2228x1652:
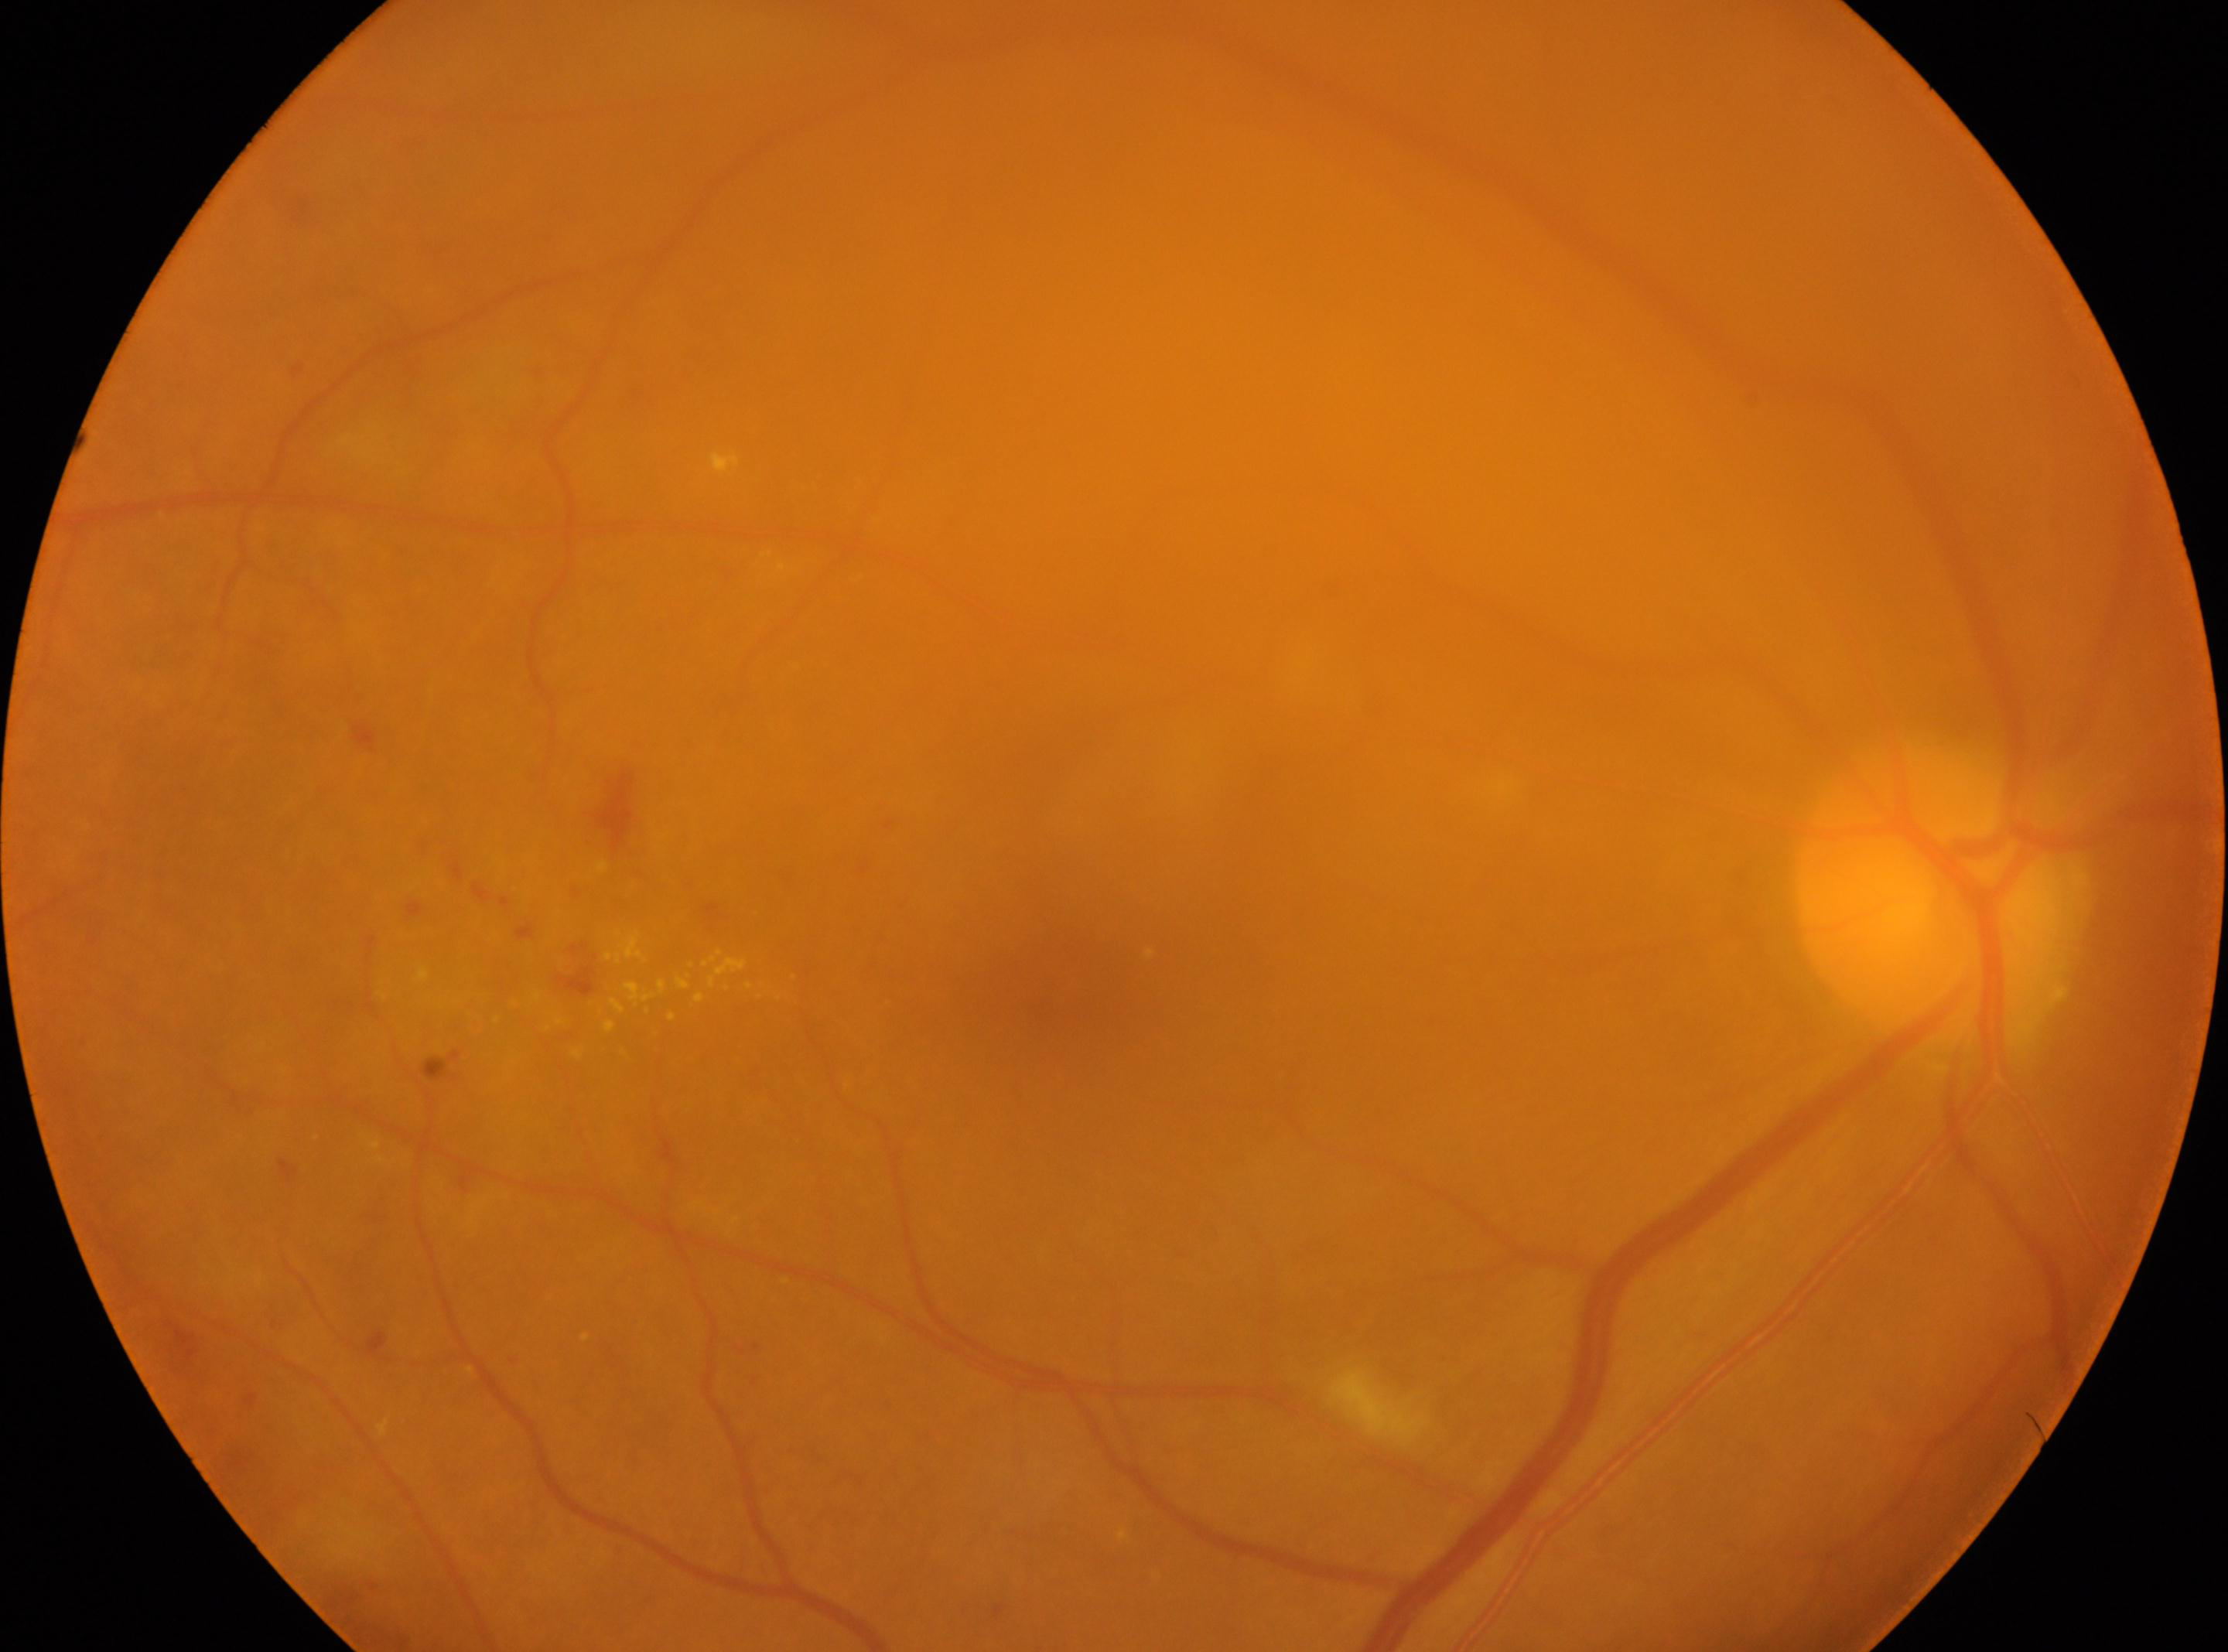
- laterality · the right eye
- the optic disc · (1929, 897)
- foveal center · (1041, 982)
- diabetic retinopathy grade · 2
- DR class · non-proliferative diabetic retinopathy